Modified Davis grading, nonmydriatic fundus photograph, camera: NIDEK AFC-230: 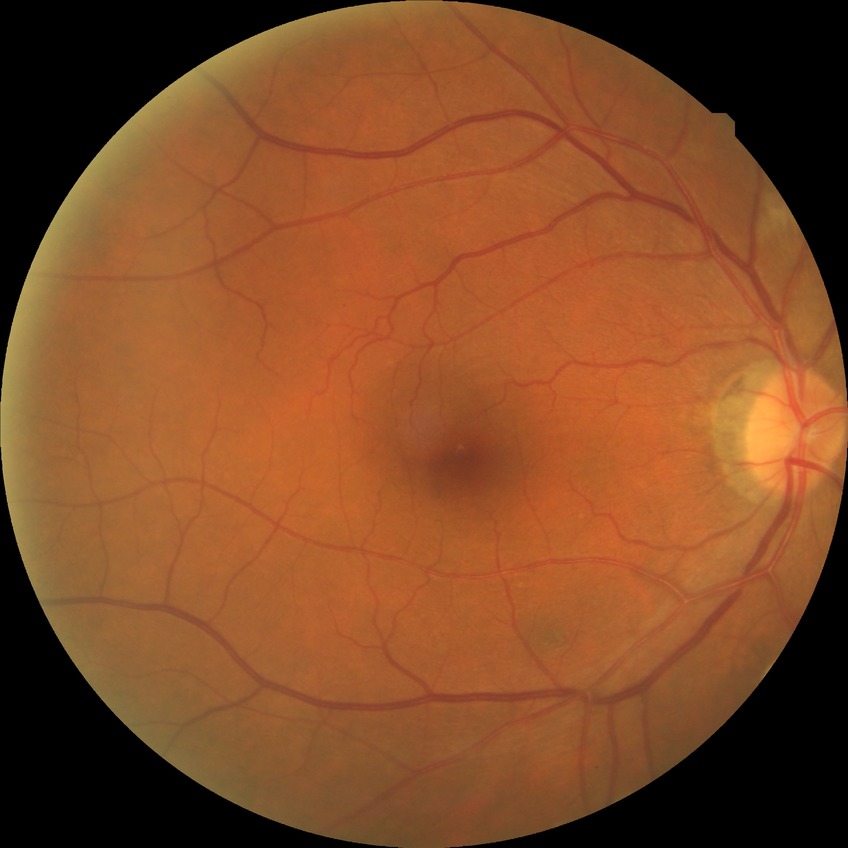 Modified Davis grading: simple diabetic retinopathy.